CFP
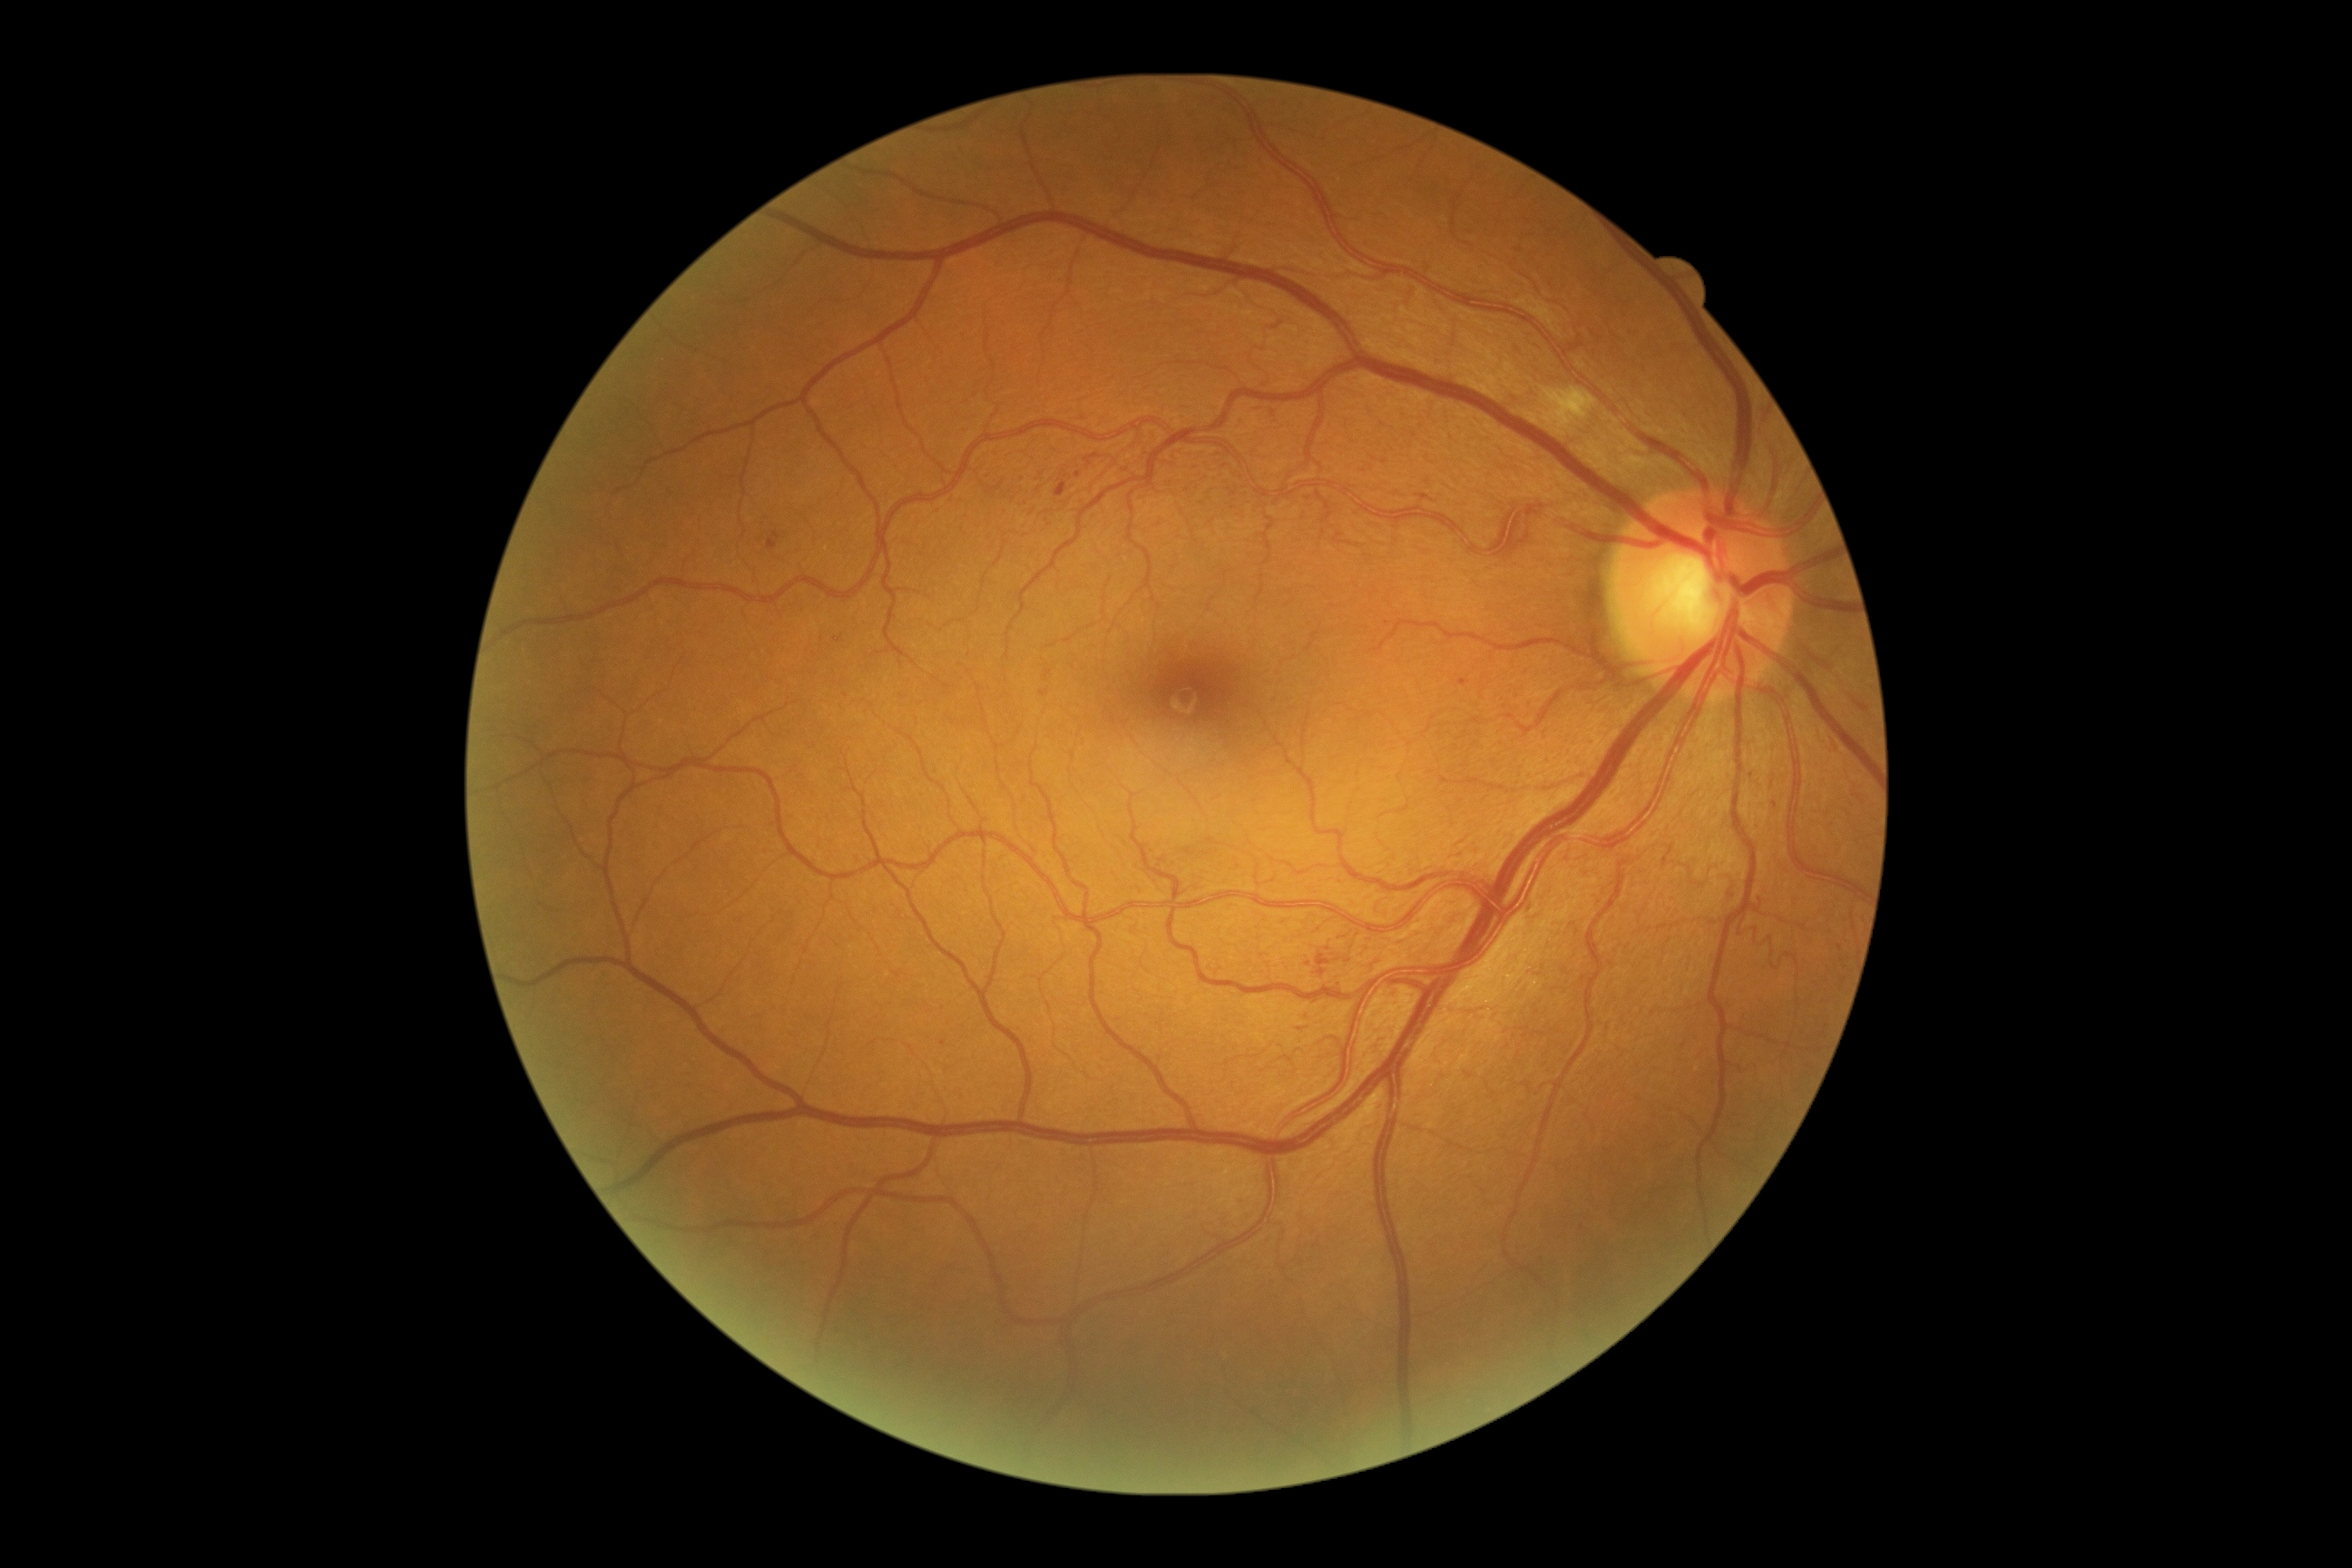

{
  "dr_grade": "moderate NPDR (grade 2)"
}